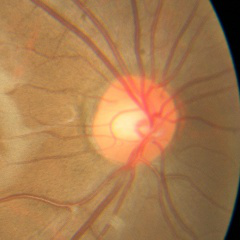

No glaucomatous optic neuropathy.